45° field of view: 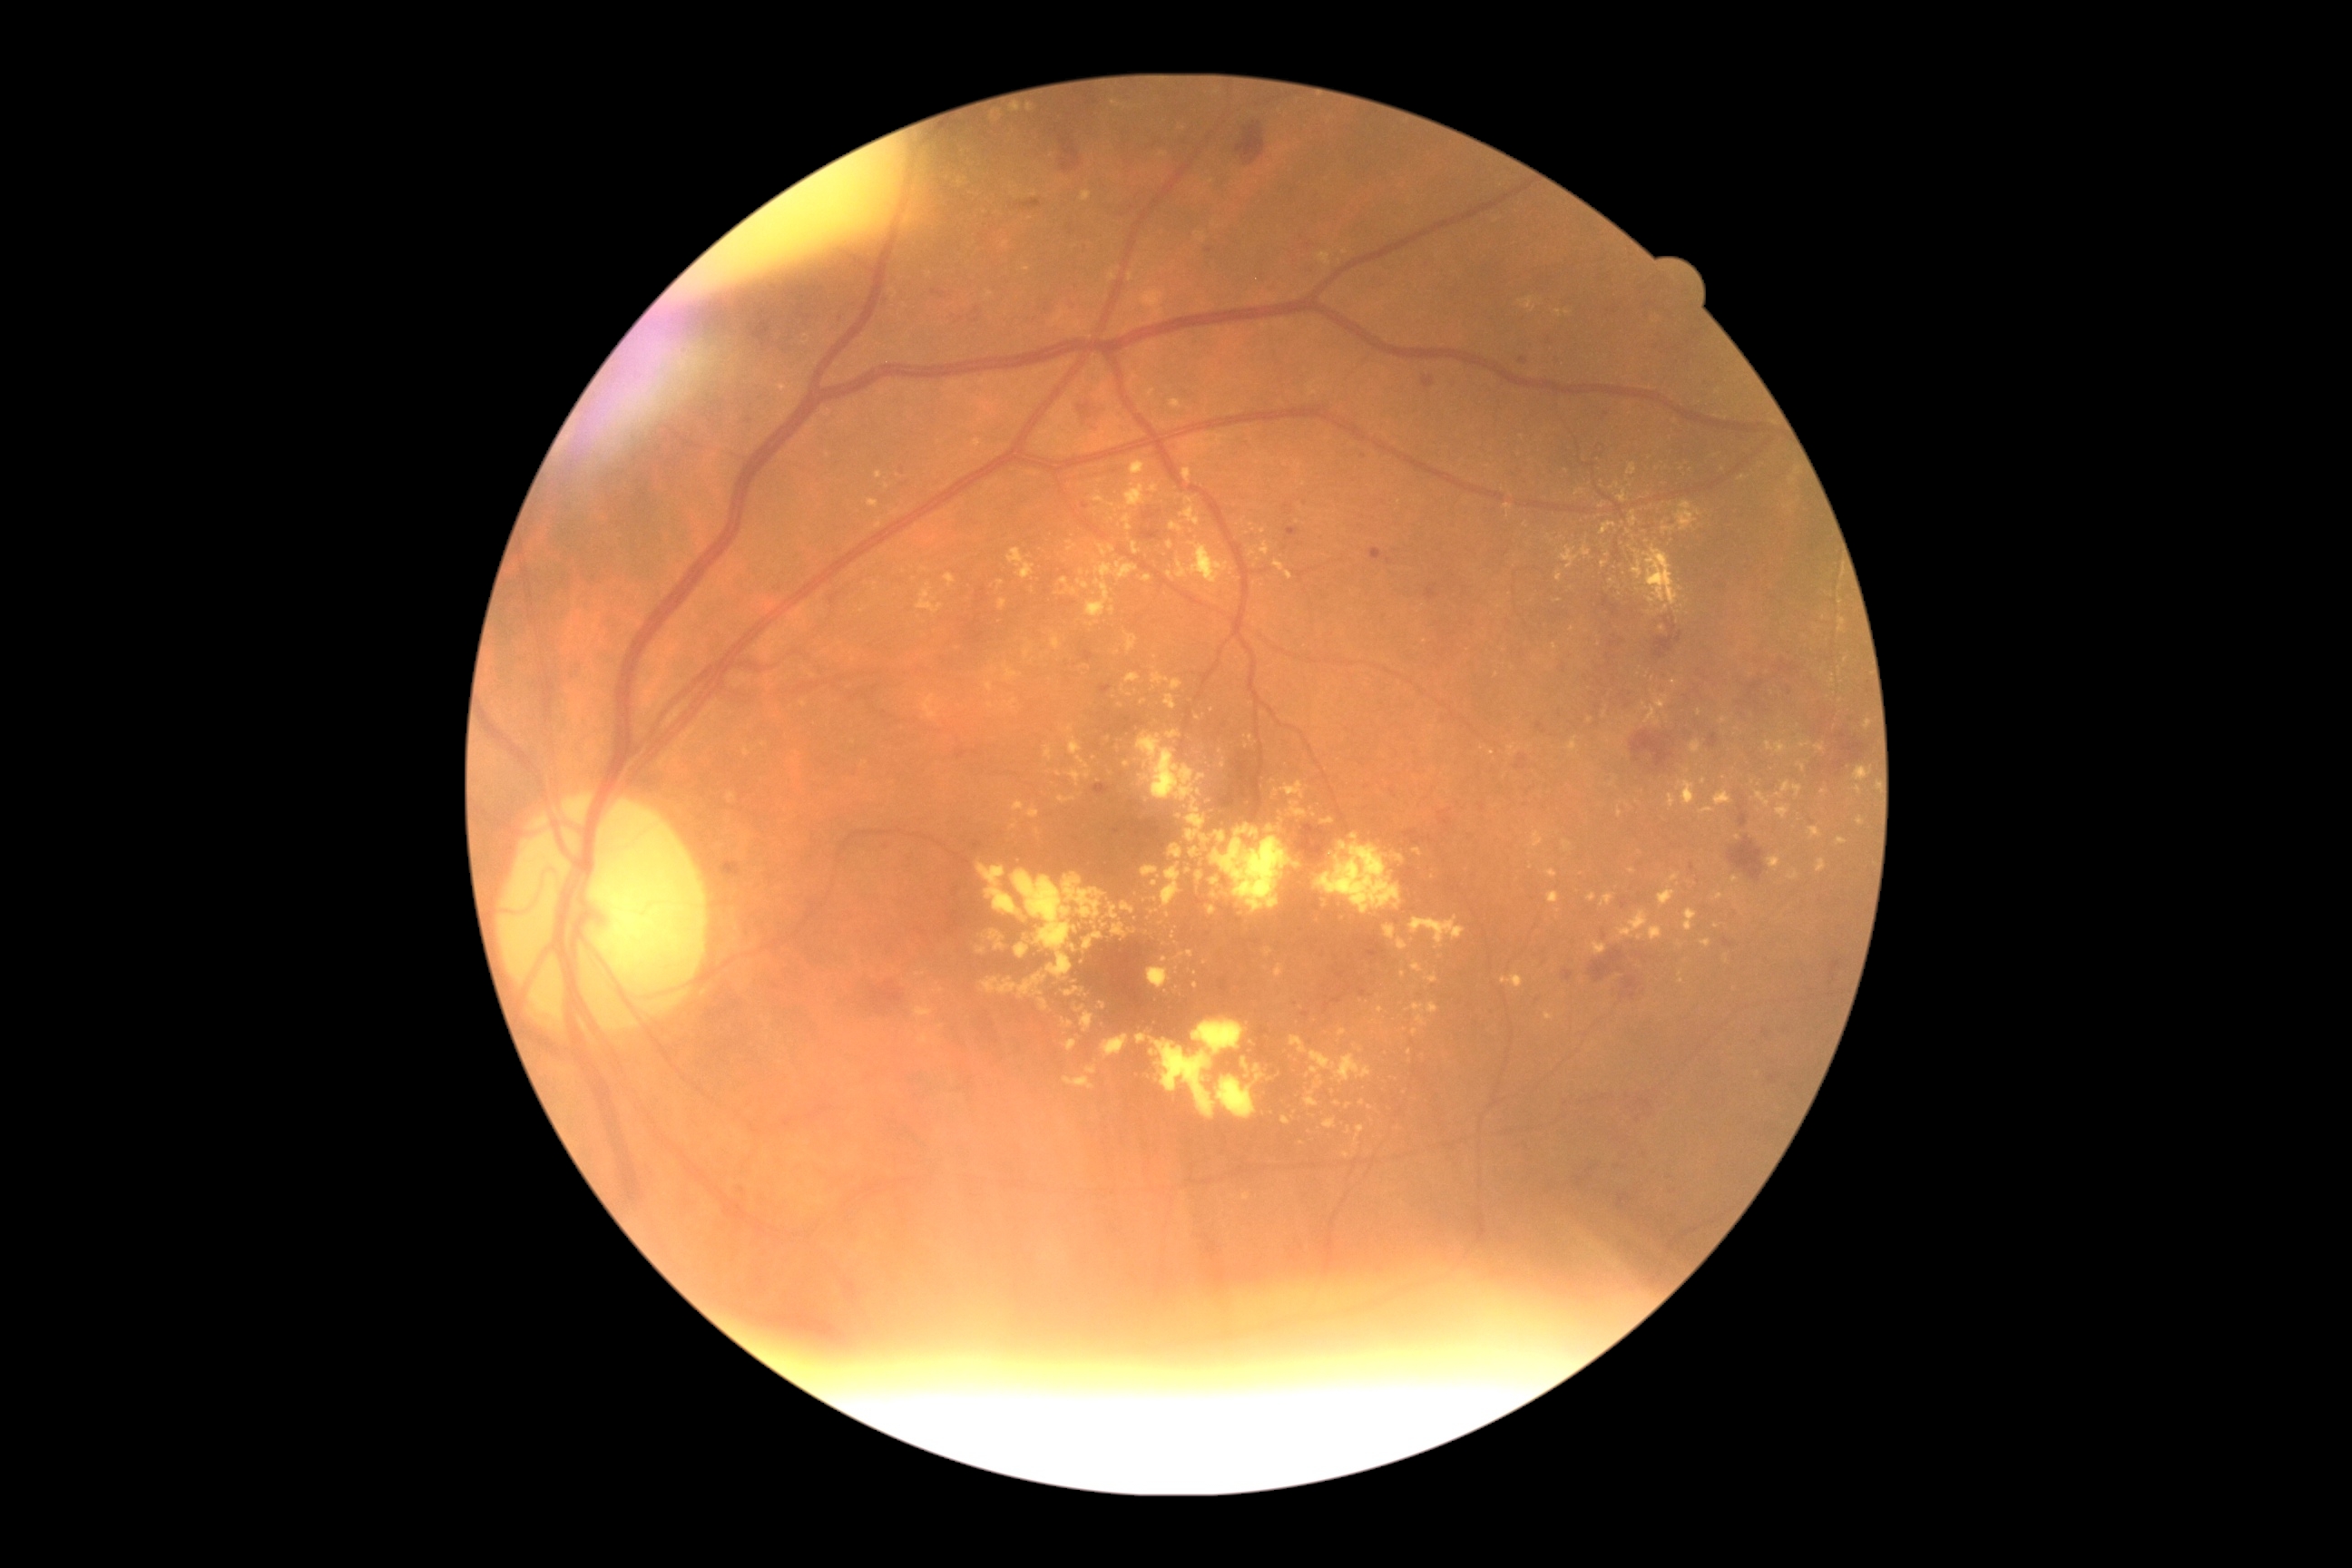

{"partial": true, "dr_grade": 2, "lesions": {"ex": [[1152, 1039, 1217, 1119], [1110, 905, 1119, 921], [1289, 1035, 1308, 1054], [916, 974, 925, 977], [1799, 741, 1812, 749], [1396, 854, 1404, 863], [1206, 799, 1217, 807], [1600, 522, 1616, 536], [1818, 859, 1827, 872], [1066, 756, 1092, 787], [916, 1008, 934, 1017], [1166, 730, 1181, 740]], "ex_small": [[1015, 827], [1719, 897], [886, 487], [1154, 1053], [1302, 1144], [1033, 590], [1370, 1109]]}}